Retinal fundus photograph
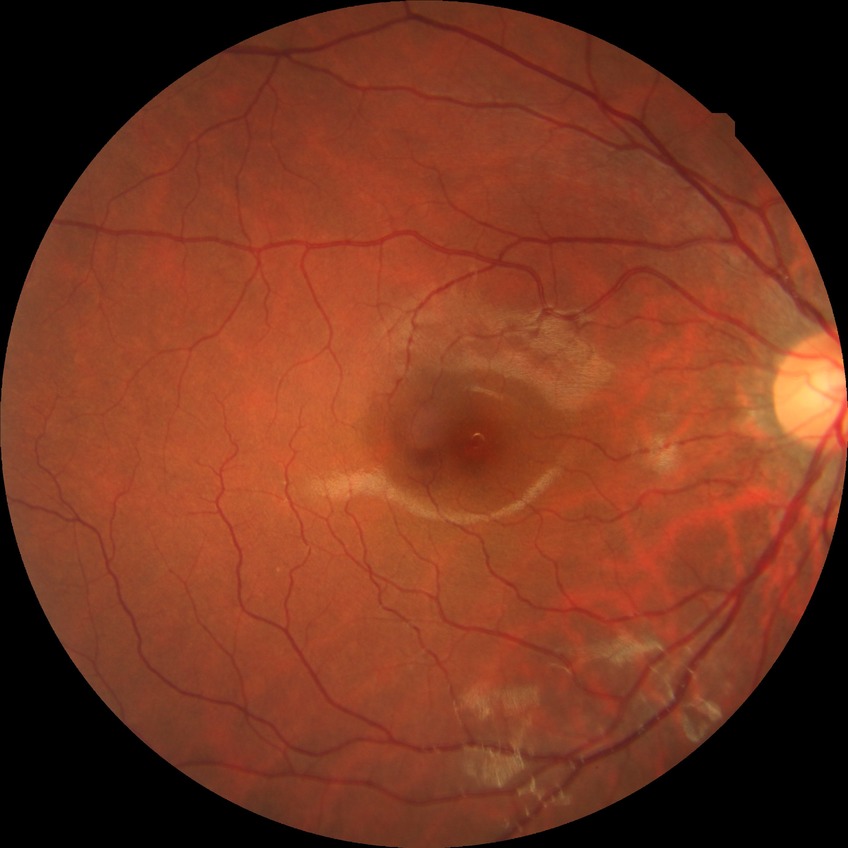 Annotations:
• retinopathy grade: no diabetic retinopathy